45-degree field of view
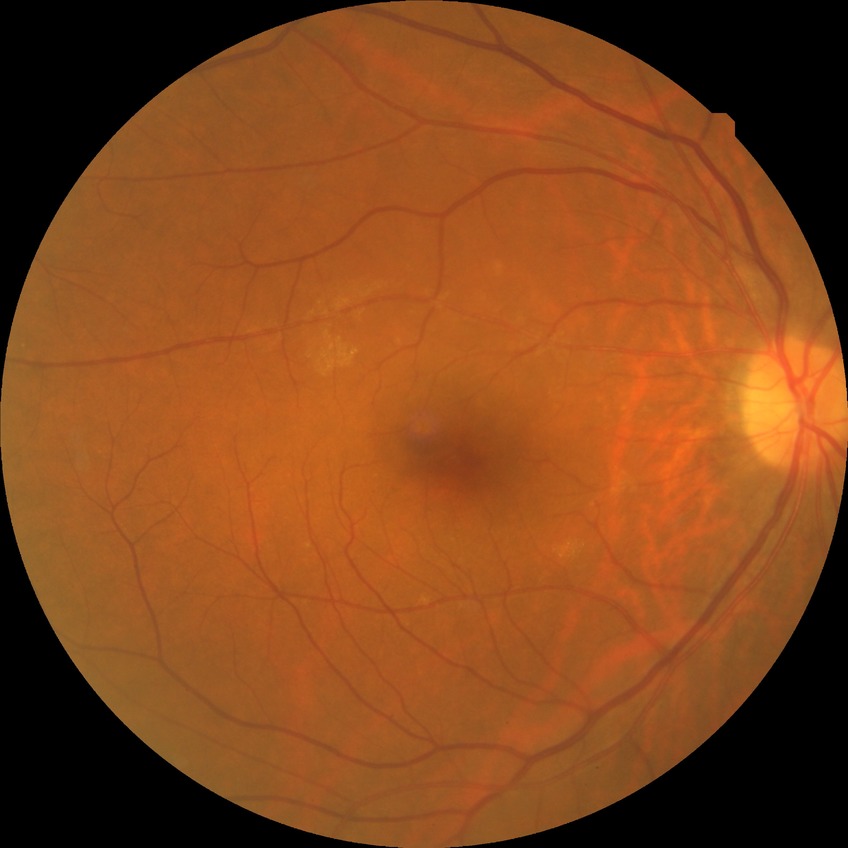   davis_grade: SDR